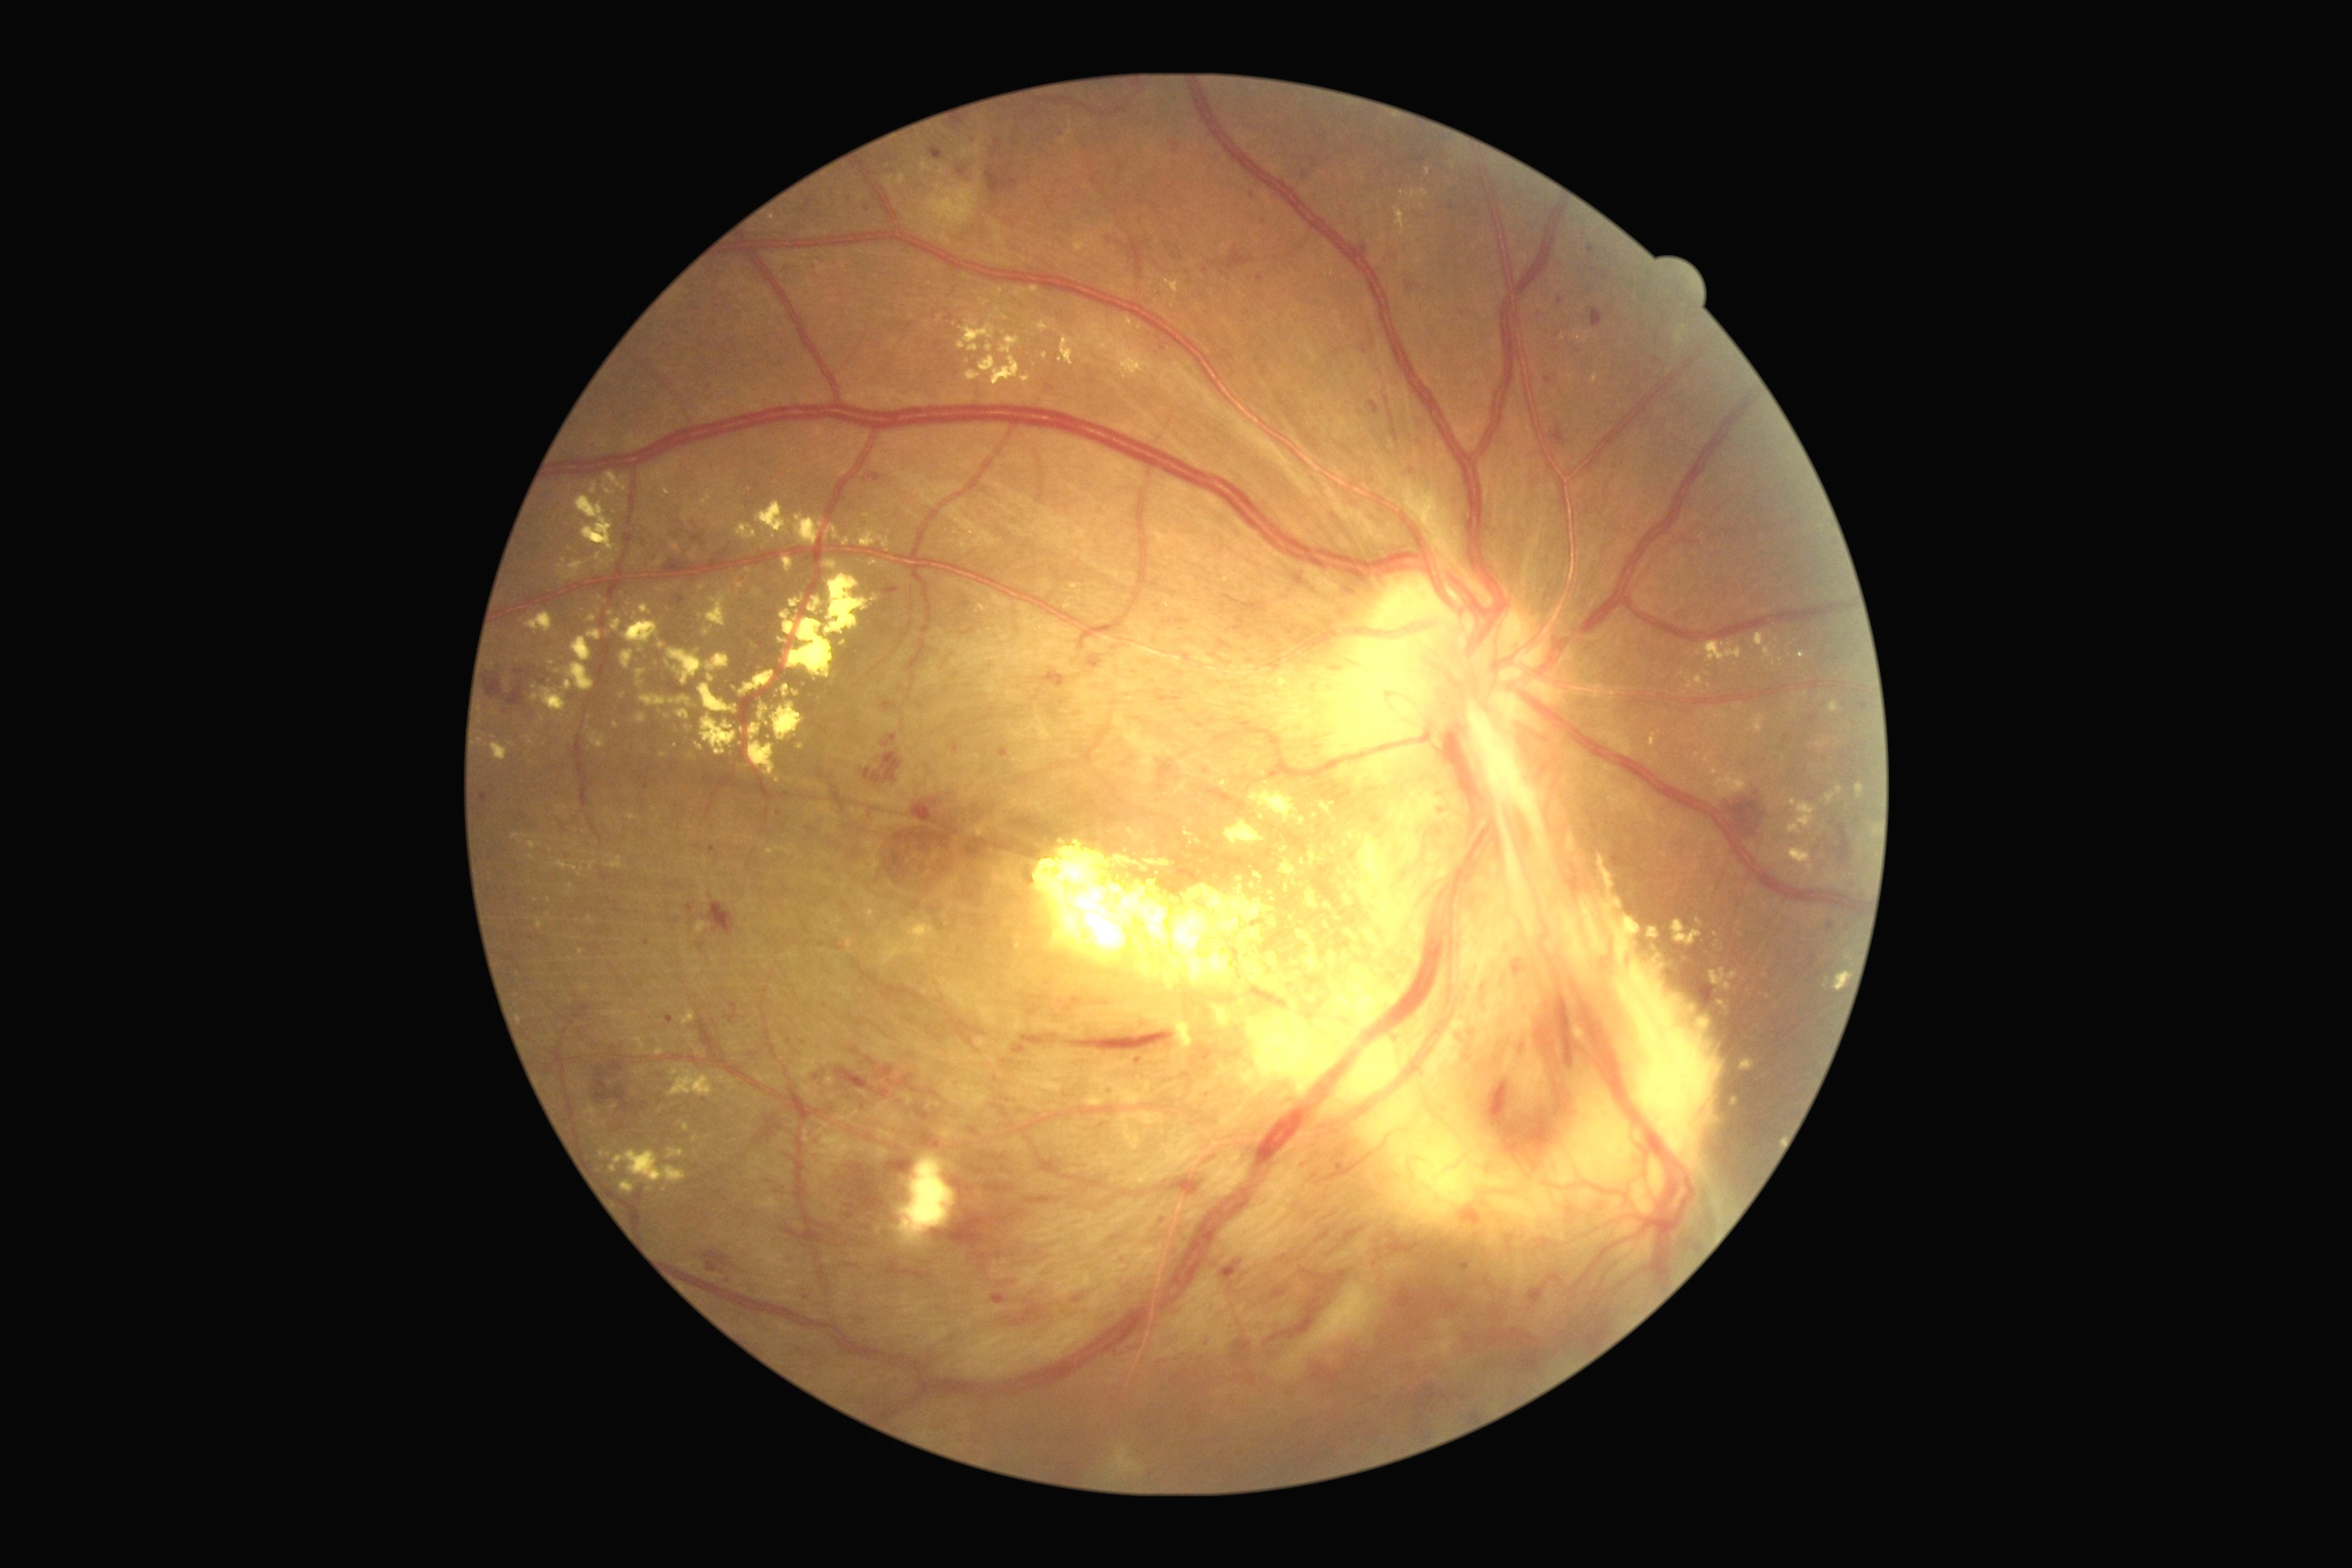 Diabetic retinopathy (DR) is proliferative diabetic retinopathy (grade 4) — neovascularization and/or vitreous/pre-retinal hemorrhage
A subset of detected lesions:
microaneurysms (MAs) (partial): x1=1841 y1=752 x2=1848 y2=760; x1=999 y1=747 x2=1008 y2=758; x1=667 y1=1015 x2=674 y2=1024; x1=1828 y1=923 x2=1836 y2=932; x1=643 y1=941 x2=651 y2=946; x1=1553 y1=335 x2=1565 y2=342; x1=1533 y1=308 x2=1544 y2=317; x1=930 y1=148 x2=945 y2=161; x1=1545 y1=377 x2=1553 y2=386; x1=819 y1=943 x2=827 y2=948
Small MAs near (1264; 223); (1560; 302); (1412; 472); (1813; 720); (789; 1041); (705; 1100); (712; 850)
soft exudates (SEs): x1=963 y1=137 x2=985 y2=157; x1=1282 y1=1259 x2=1407 y2=1369; x1=925 y1=184 x2=977 y2=231
hemorrhages (HEs) (partial): x1=1384 y1=251 x2=1404 y2=262; x1=1460 y1=1260 x2=1471 y2=1271; x1=917 y1=1108 x2=930 y2=1121; x1=594 y1=1066 x2=631 y2=1112; x1=1493 y1=1010 x2=1571 y2=1157; x1=1043 y1=672 x2=1066 y2=689; x1=805 y1=199 x2=814 y2=208; x1=825 y1=1099 x2=836 y2=1115; x1=1110 y1=240 x2=1139 y2=273; x1=1415 y1=1387 x2=1436 y2=1418; x1=877 y1=1066 x2=919 y2=1093; x1=1220 y1=271 x2=1228 y2=277; x1=1073 y1=1297 x2=1083 y2=1304; x1=1195 y1=723 x2=1206 y2=729; x1=1458 y1=1208 x2=1484 y2=1230; x1=1406 y1=282 x2=1418 y2=293; x1=985 y1=1184 x2=1014 y2=1193; x1=883 y1=734 x2=897 y2=747; x1=1698 y1=981 x2=1714 y2=1008; x1=1064 y1=1032 x2=1175 y2=1054
hard exudates (EXs) (partial): x1=1790 y1=705 x2=1796 y2=714; x1=632 y1=1037 x2=647 y2=1052; x1=1738 y1=1061 x2=1756 y2=1077; x1=636 y1=712 x2=649 y2=723; x1=683 y1=1124 x2=691 y2=1132; x1=1279 y1=859 x2=1298 y2=877; x1=1714 y1=966 x2=1740 y2=1010; x1=1246 y1=836 x2=1718 y2=1237; x1=640 y1=603 x2=652 y2=616; x1=1331 y1=861 x2=1351 y2=890; x1=1703 y1=754 x2=1749 y2=798; x1=589 y1=614 x2=598 y2=623; x1=696 y1=743 x2=703 y2=752; x1=1349 y1=881 x2=1364 y2=888
Small EXs near (665; 1189); (777; 780); (1292; 918); (571; 887); (801; 747); (1741; 707)